Image size 1659x2212 · color fundus photograph · captured on a Remidio FOP fundus camera
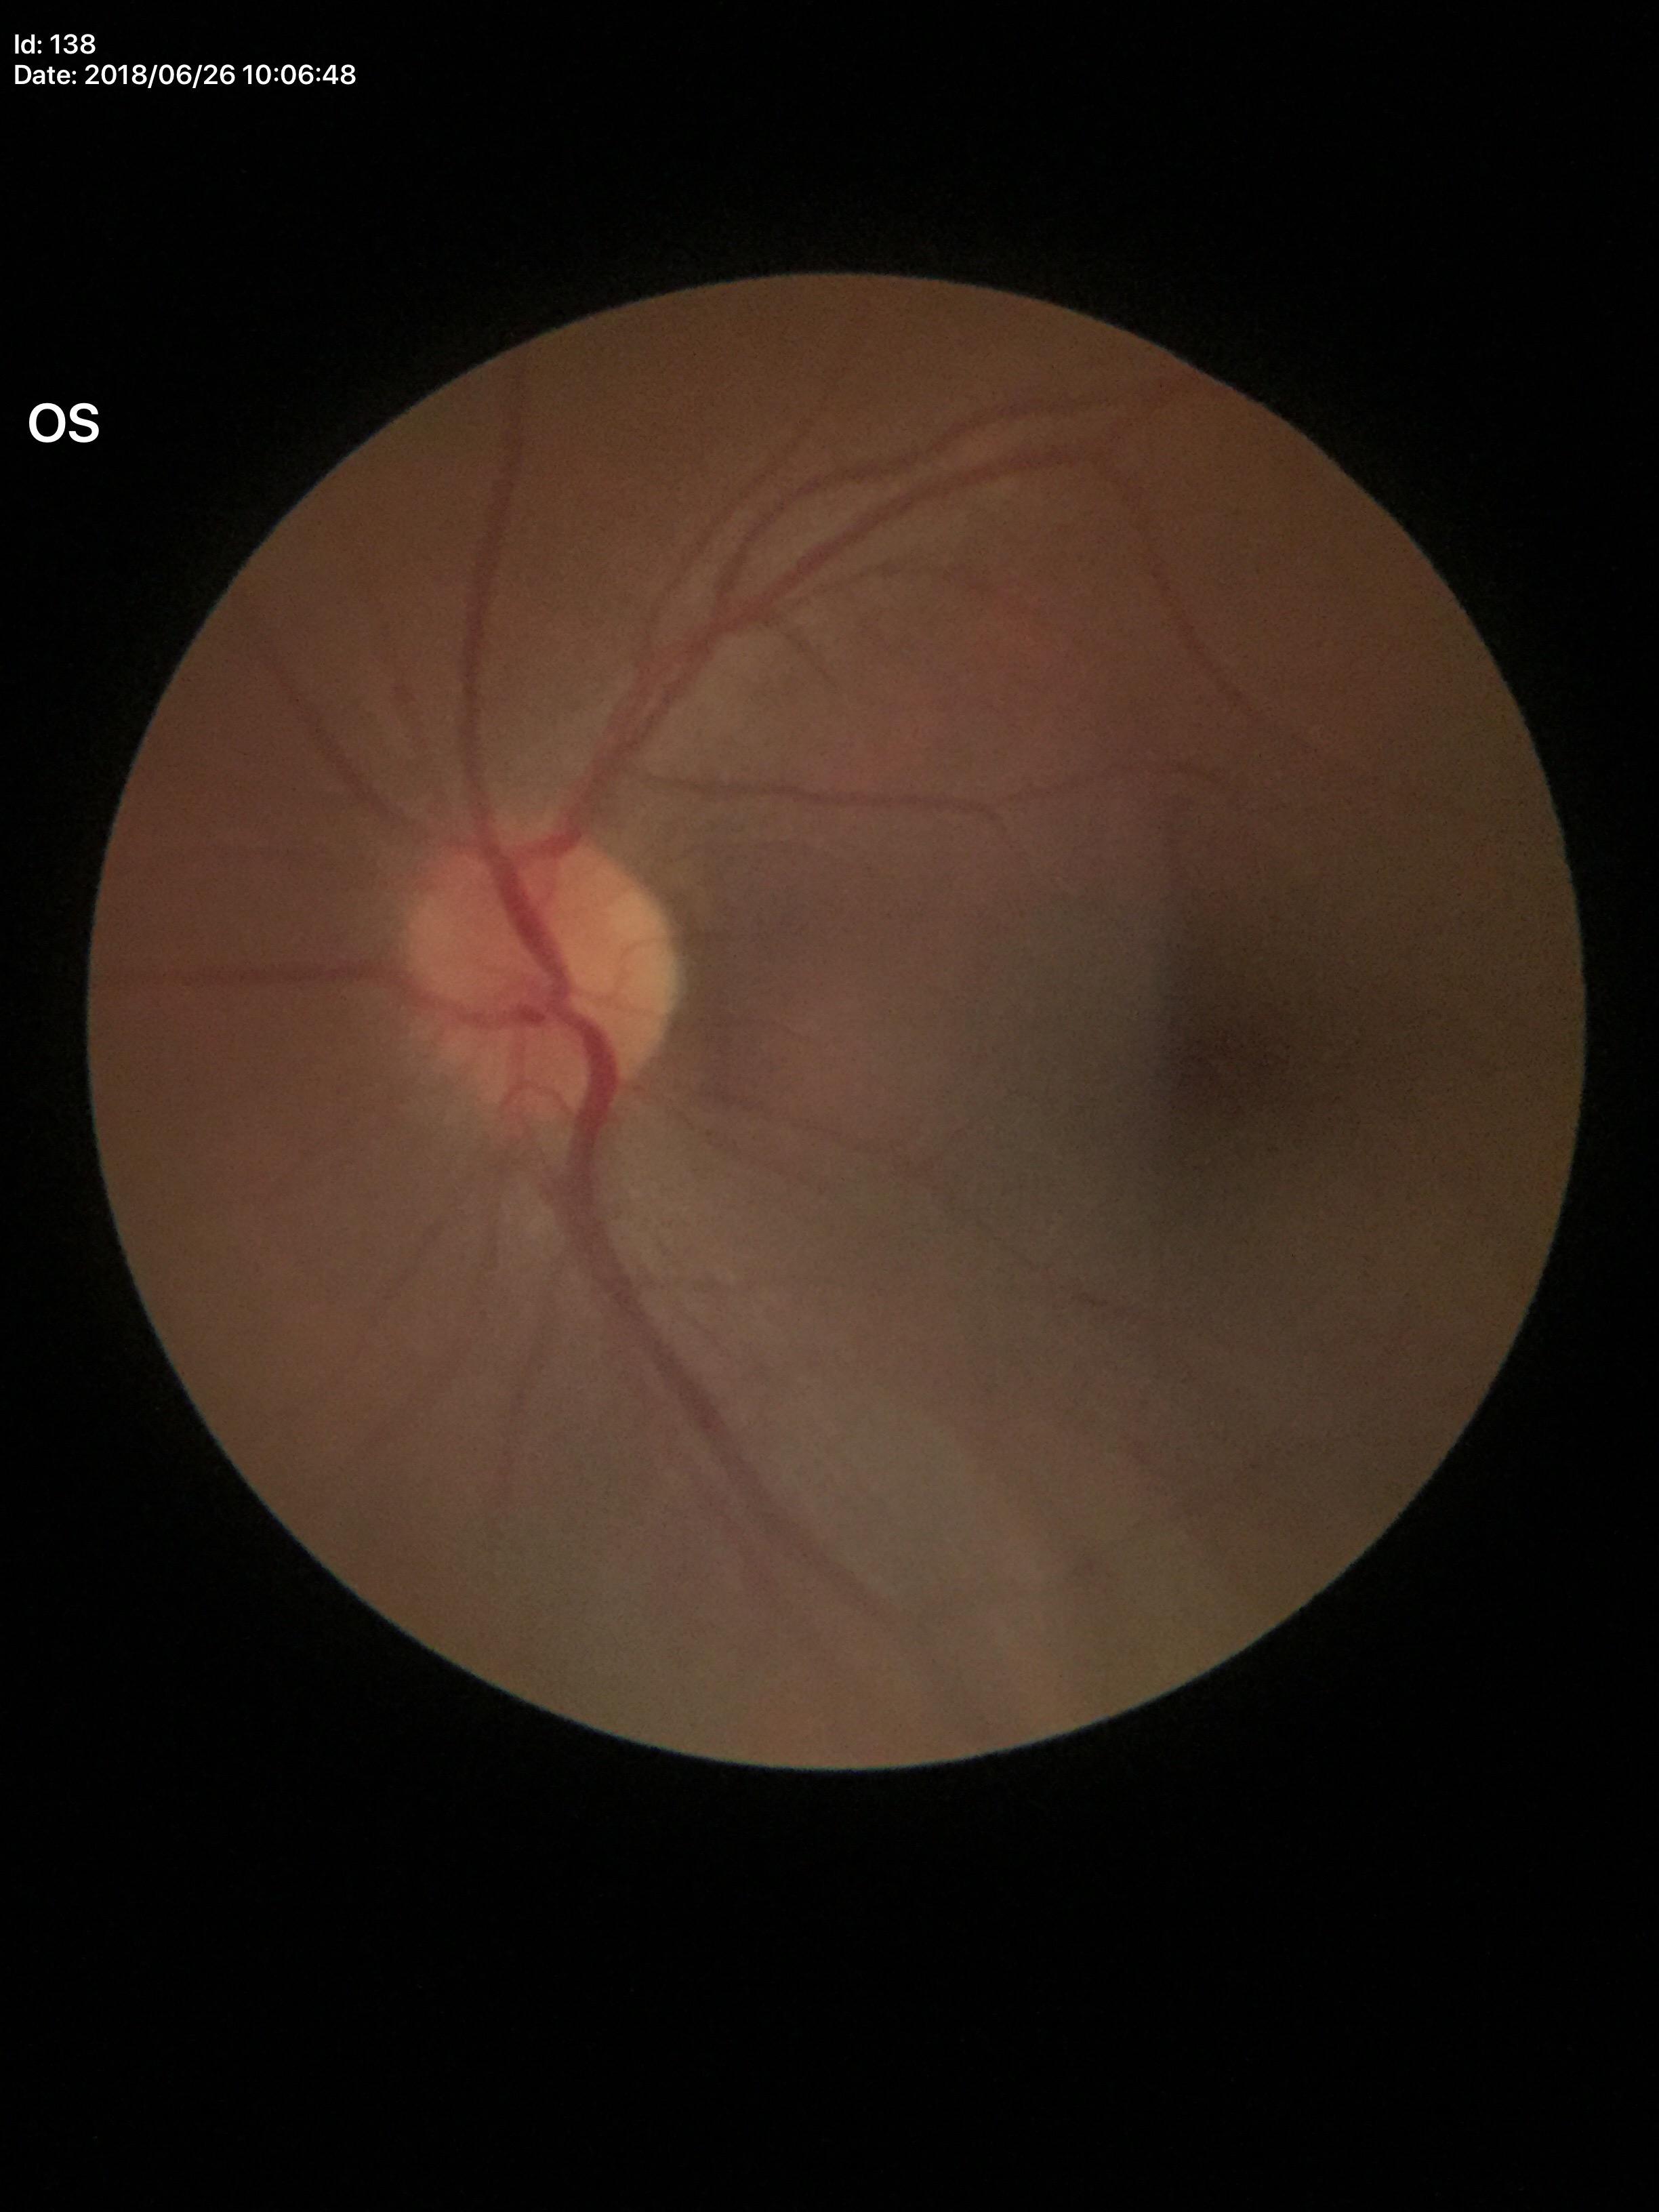
vertical CDR=0.37; Glaucoma assessment=not suspect